Diabetic retinopathy graded by the modified Davis classification.
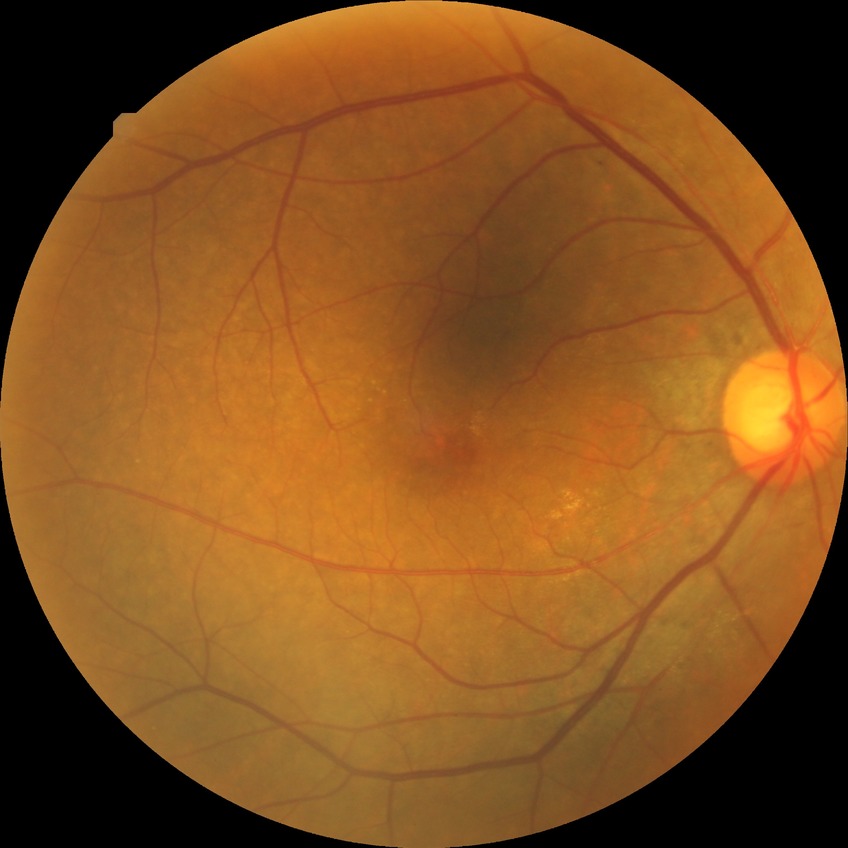

Diabetic retinopathy grade: simple diabetic retinopathy. The retinopathy is classified as non-proliferative diabetic retinopathy.